Posterior pole photograph:
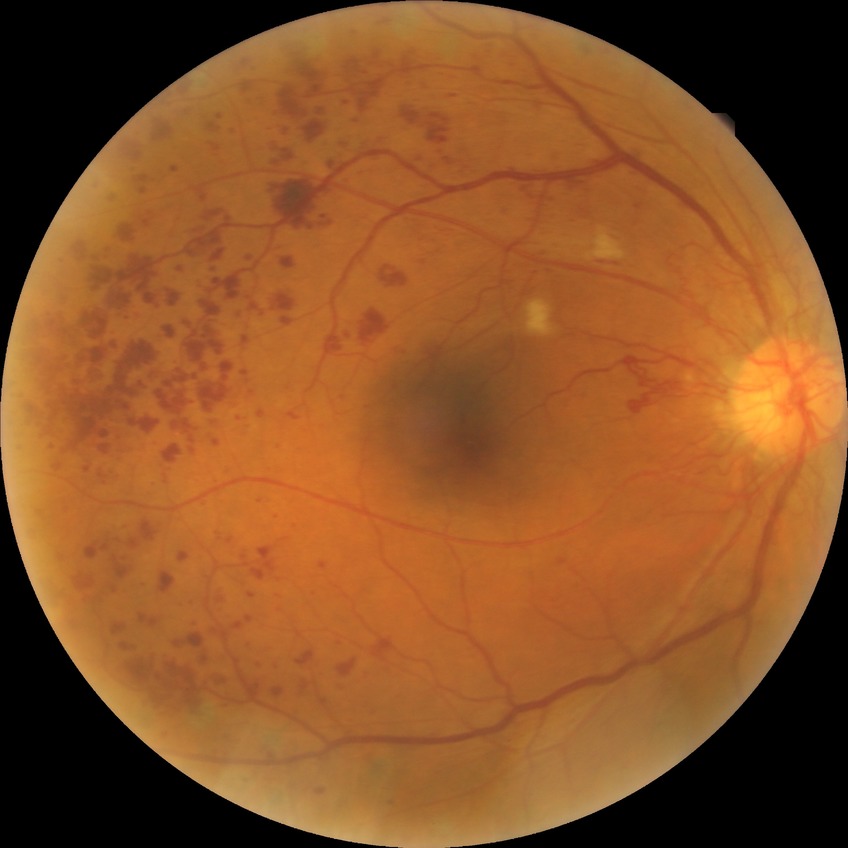   davis_grade: PDR (proliferative diabetic retinopathy)